Retinal fundus photograph
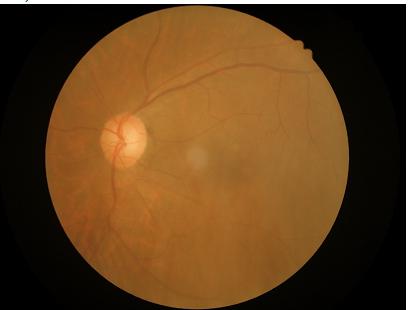 Contrast is low.
Reduced sharpness with visible blur.
Image quality is adequate for diagnostic use.